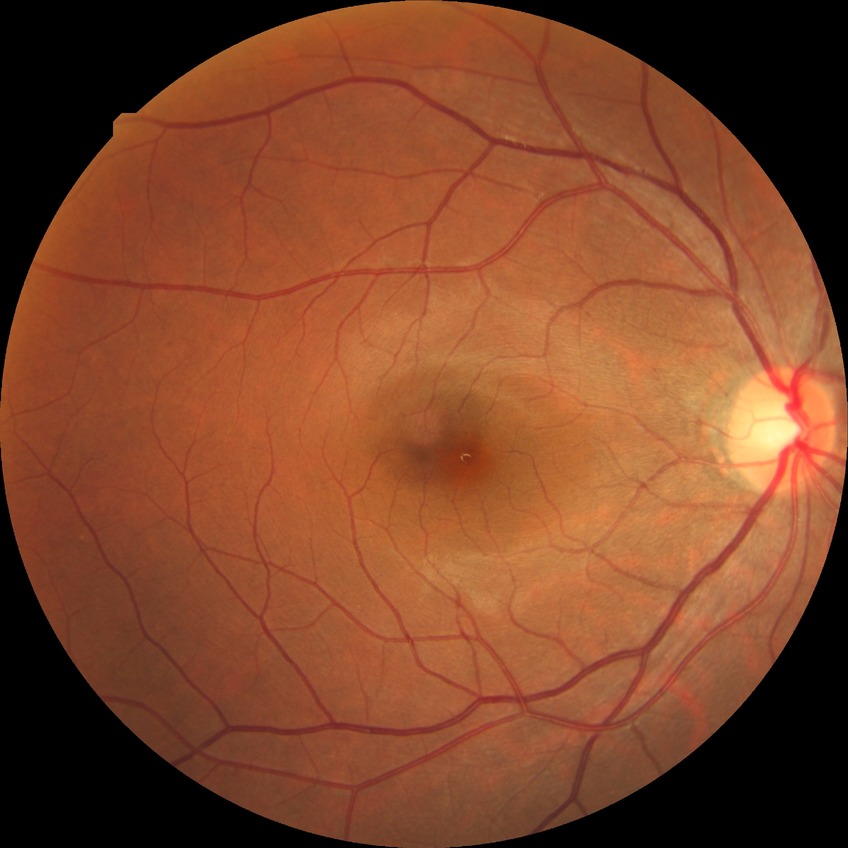 {
  "davis_grade": "NDR"
}